Fundus photo · 45° FOV · NIDEK AFC-230 fundus camera · image size 848x848:
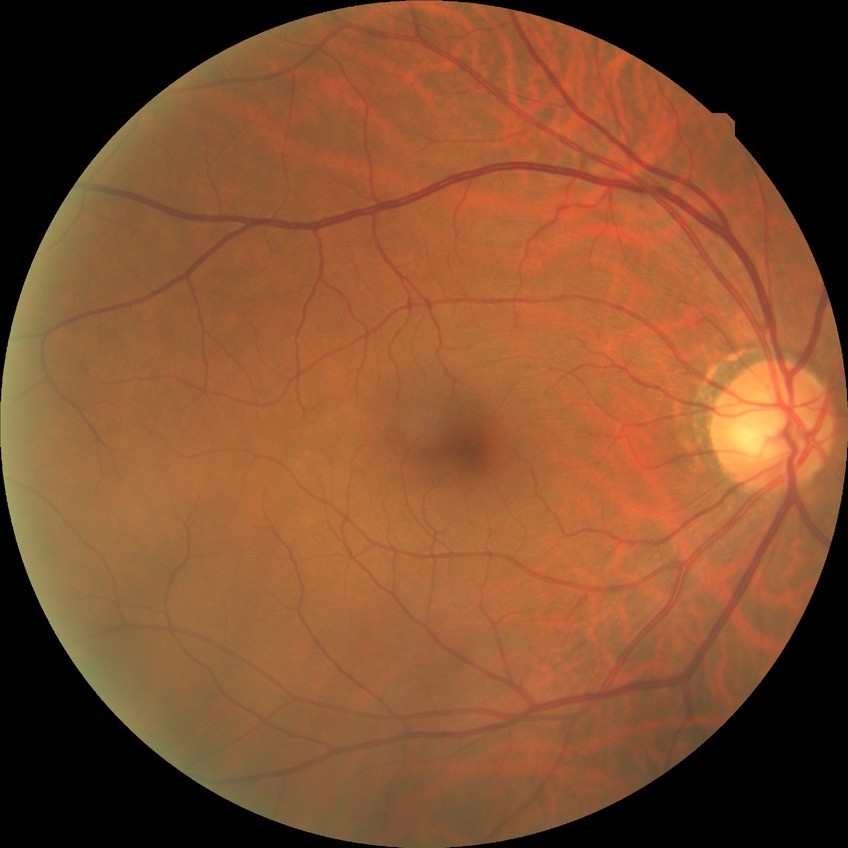 Modified Davis grading: no diabetic retinopathy.